640 x 480 pixels · infant wide-field retinal image — 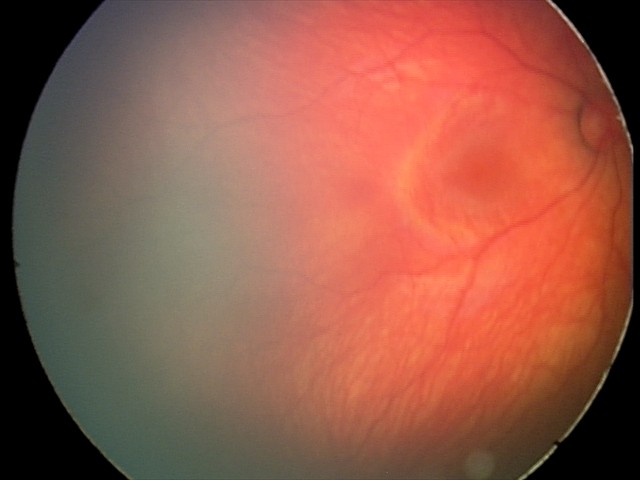

Screening examination consistent with retinal hemorrhages.